Pediatric wide-field fundus photograph · 640x480px — 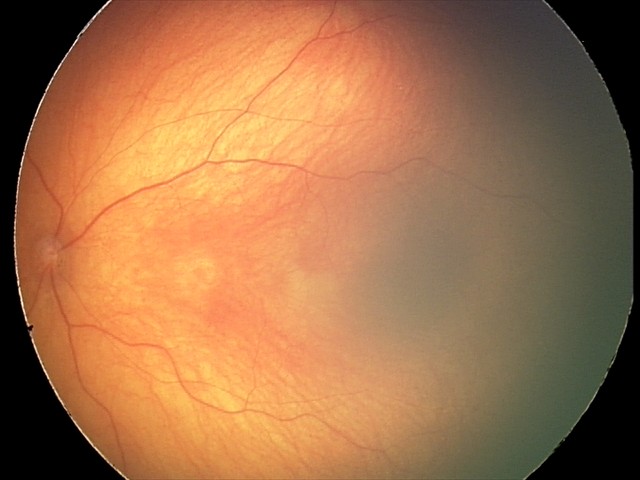
Impression: optic nerve hypoplasia.